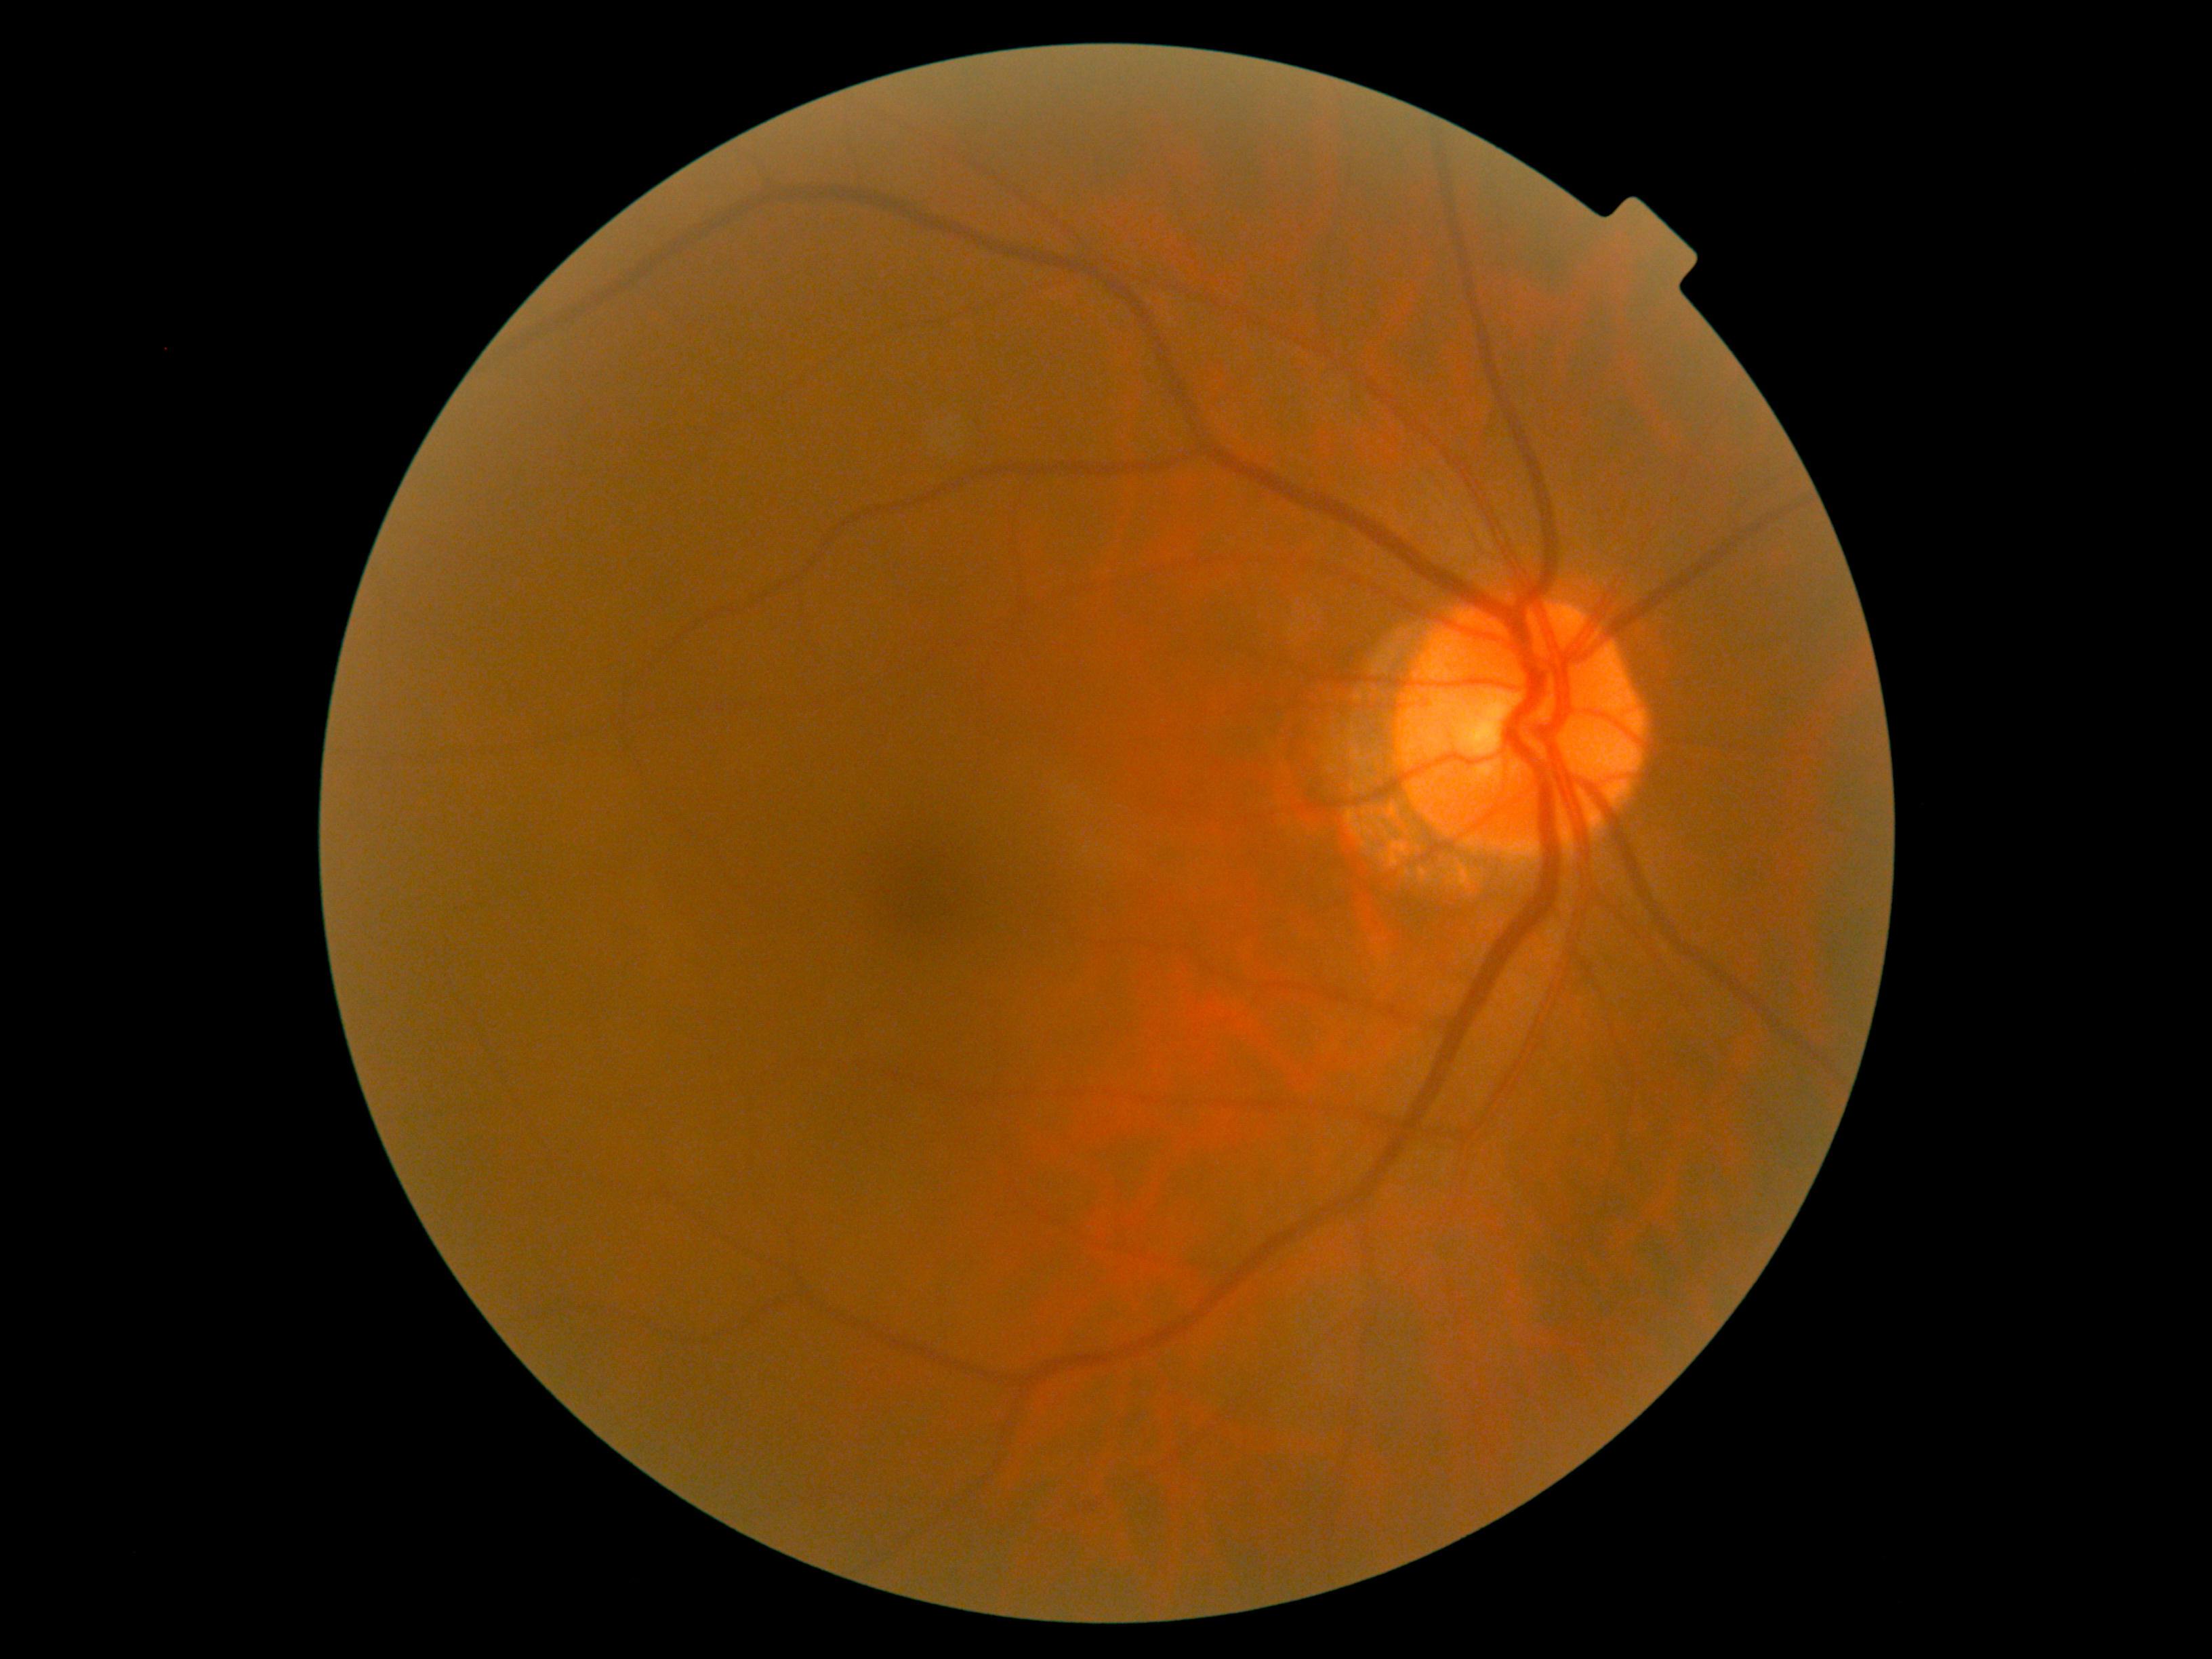 dr_grade: 0/4 — no visible signs of diabetic retinopathy
dr_impression: no signs of DR